Image size 2184x1690 — 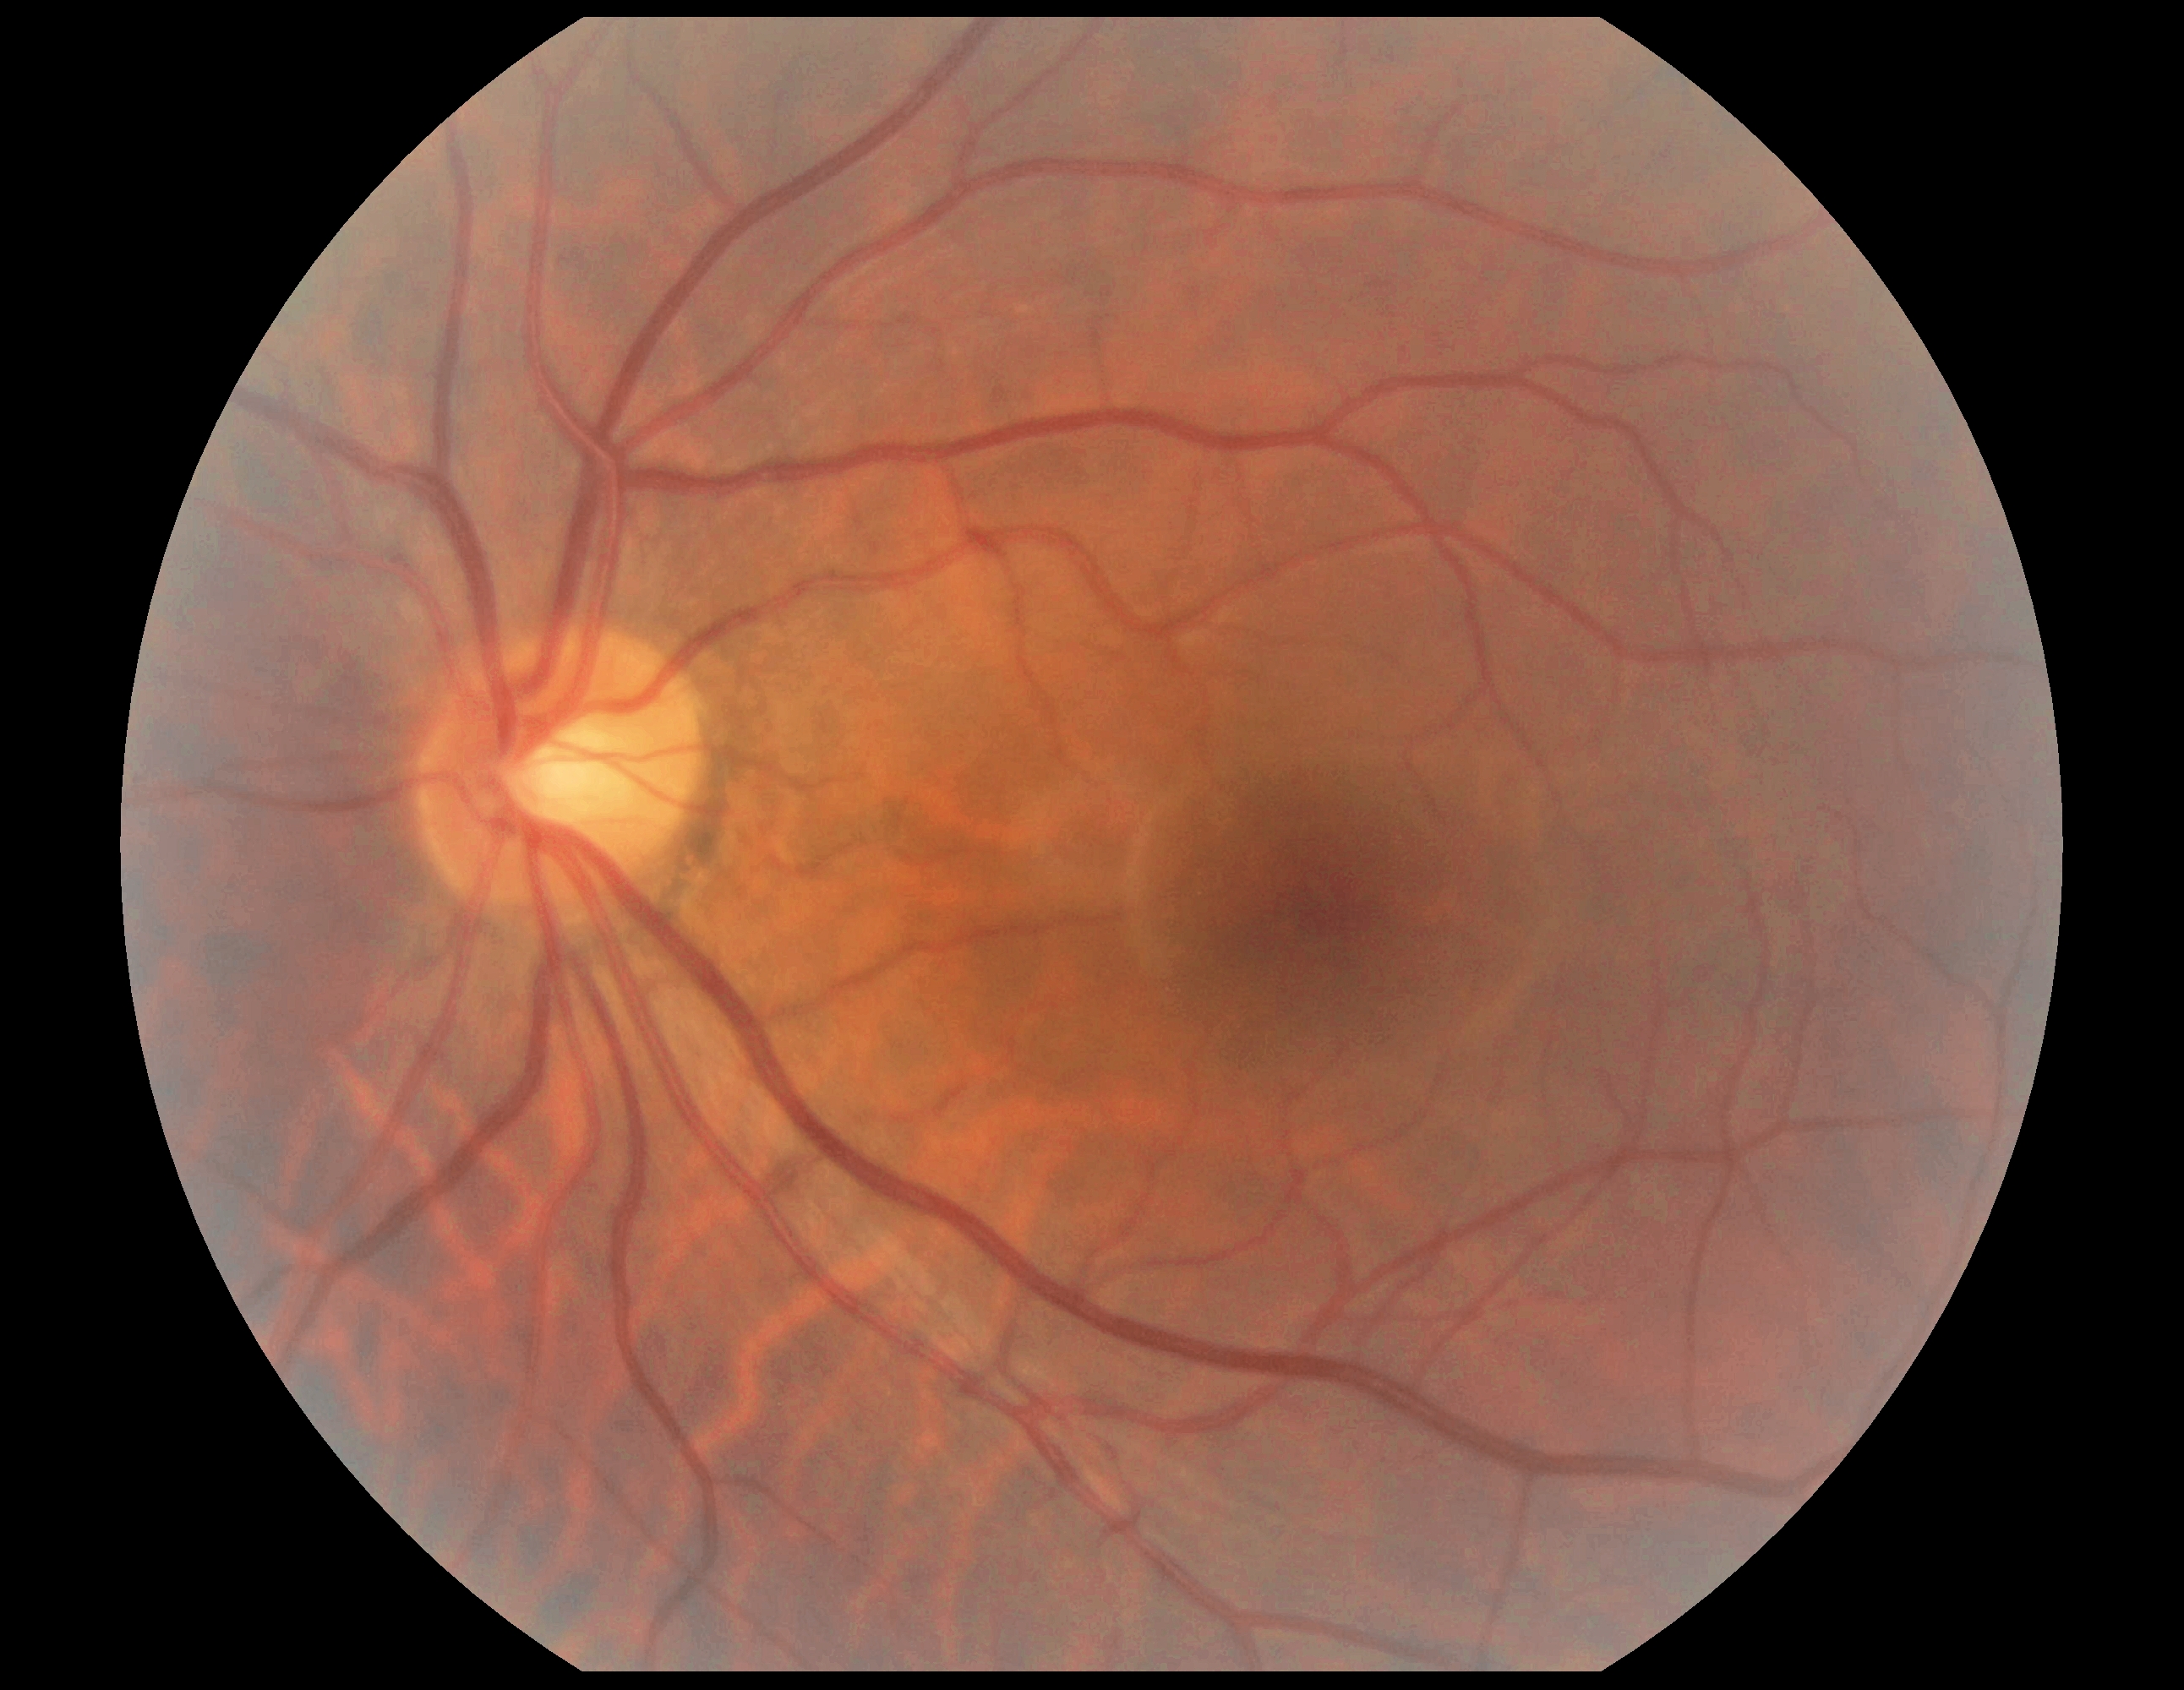 {"dr_grade": "0/4", "dr_impression": "negative for DR"}